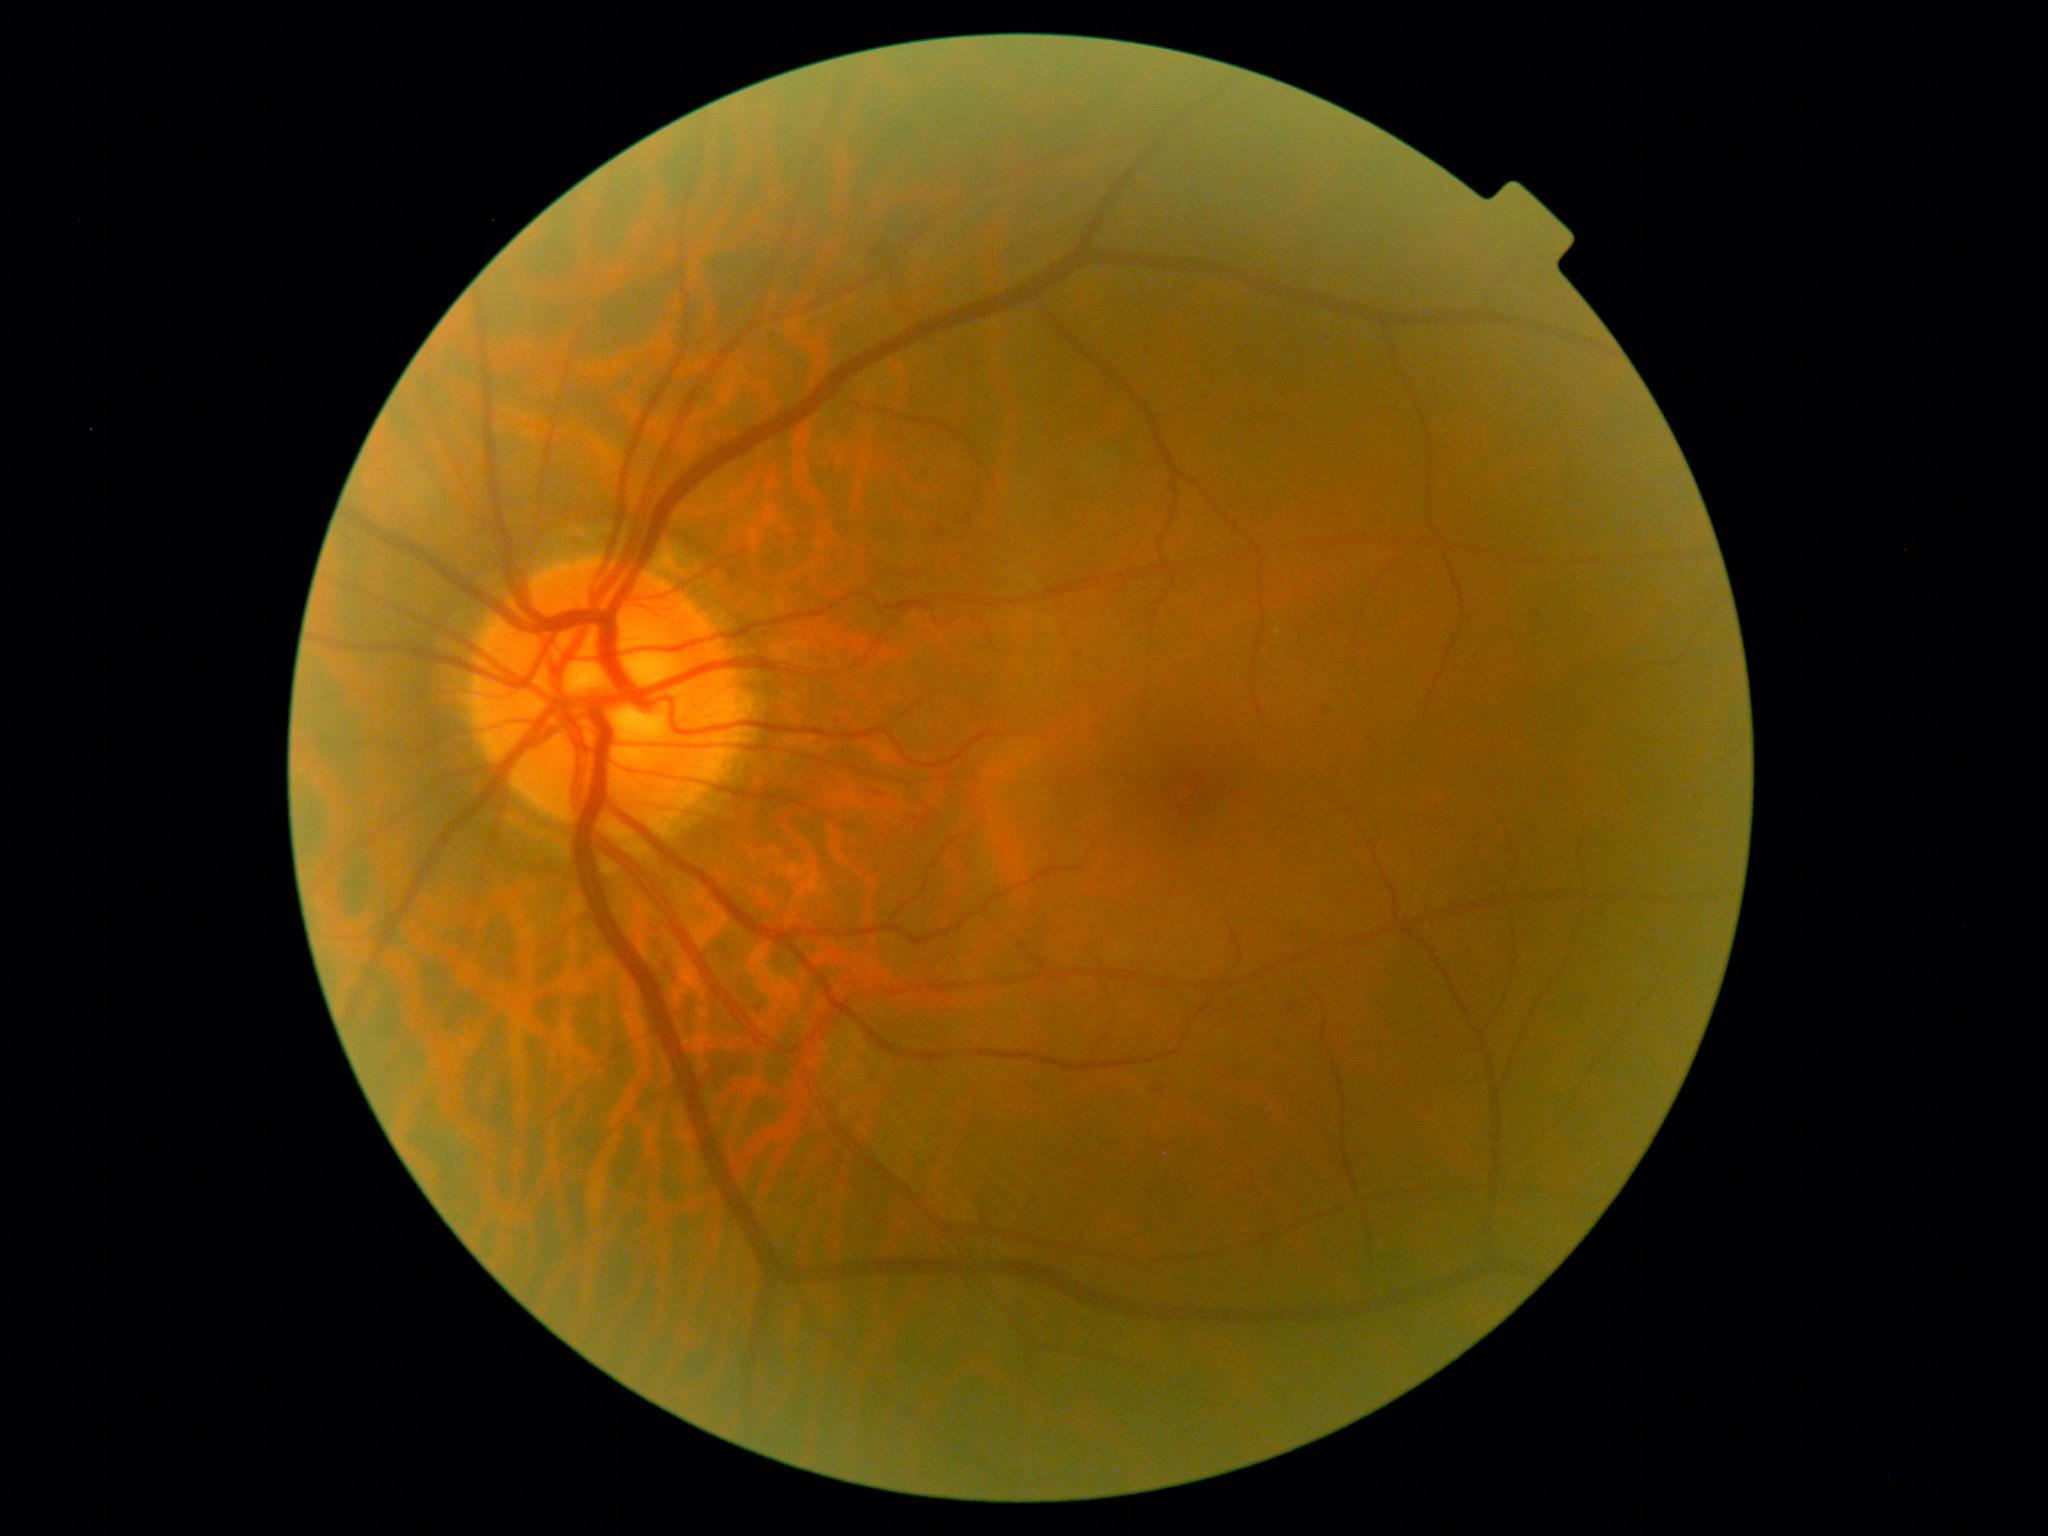

DR = 2.